45° field of view; 848 x 848 pixels:
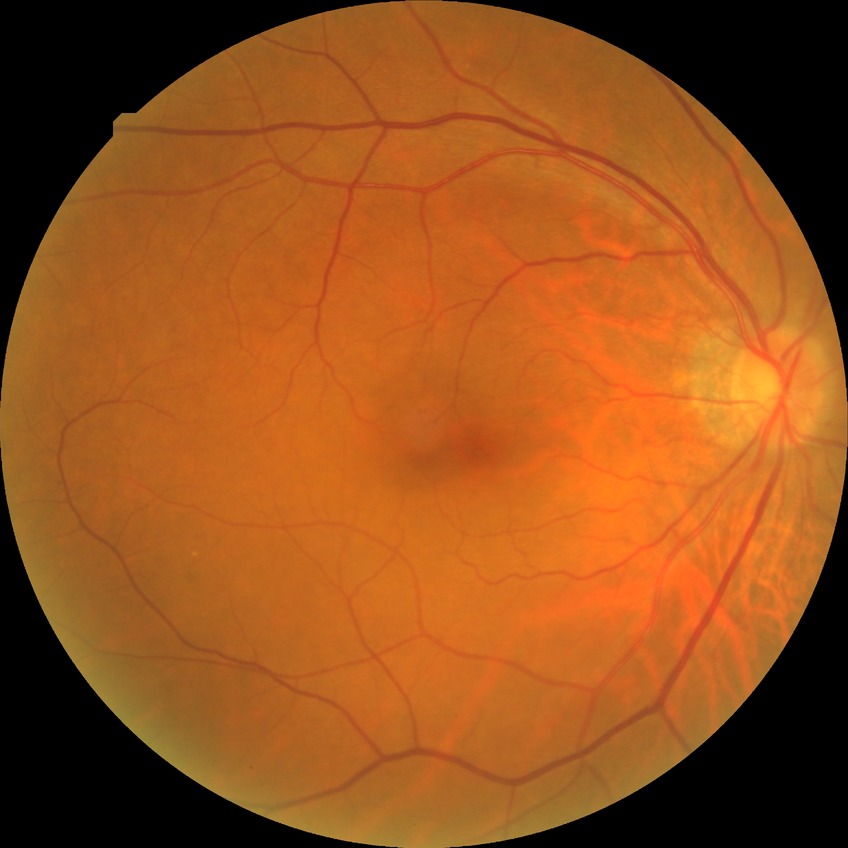 Annotations:
– modified Davis grade: NDR